45° FOV.
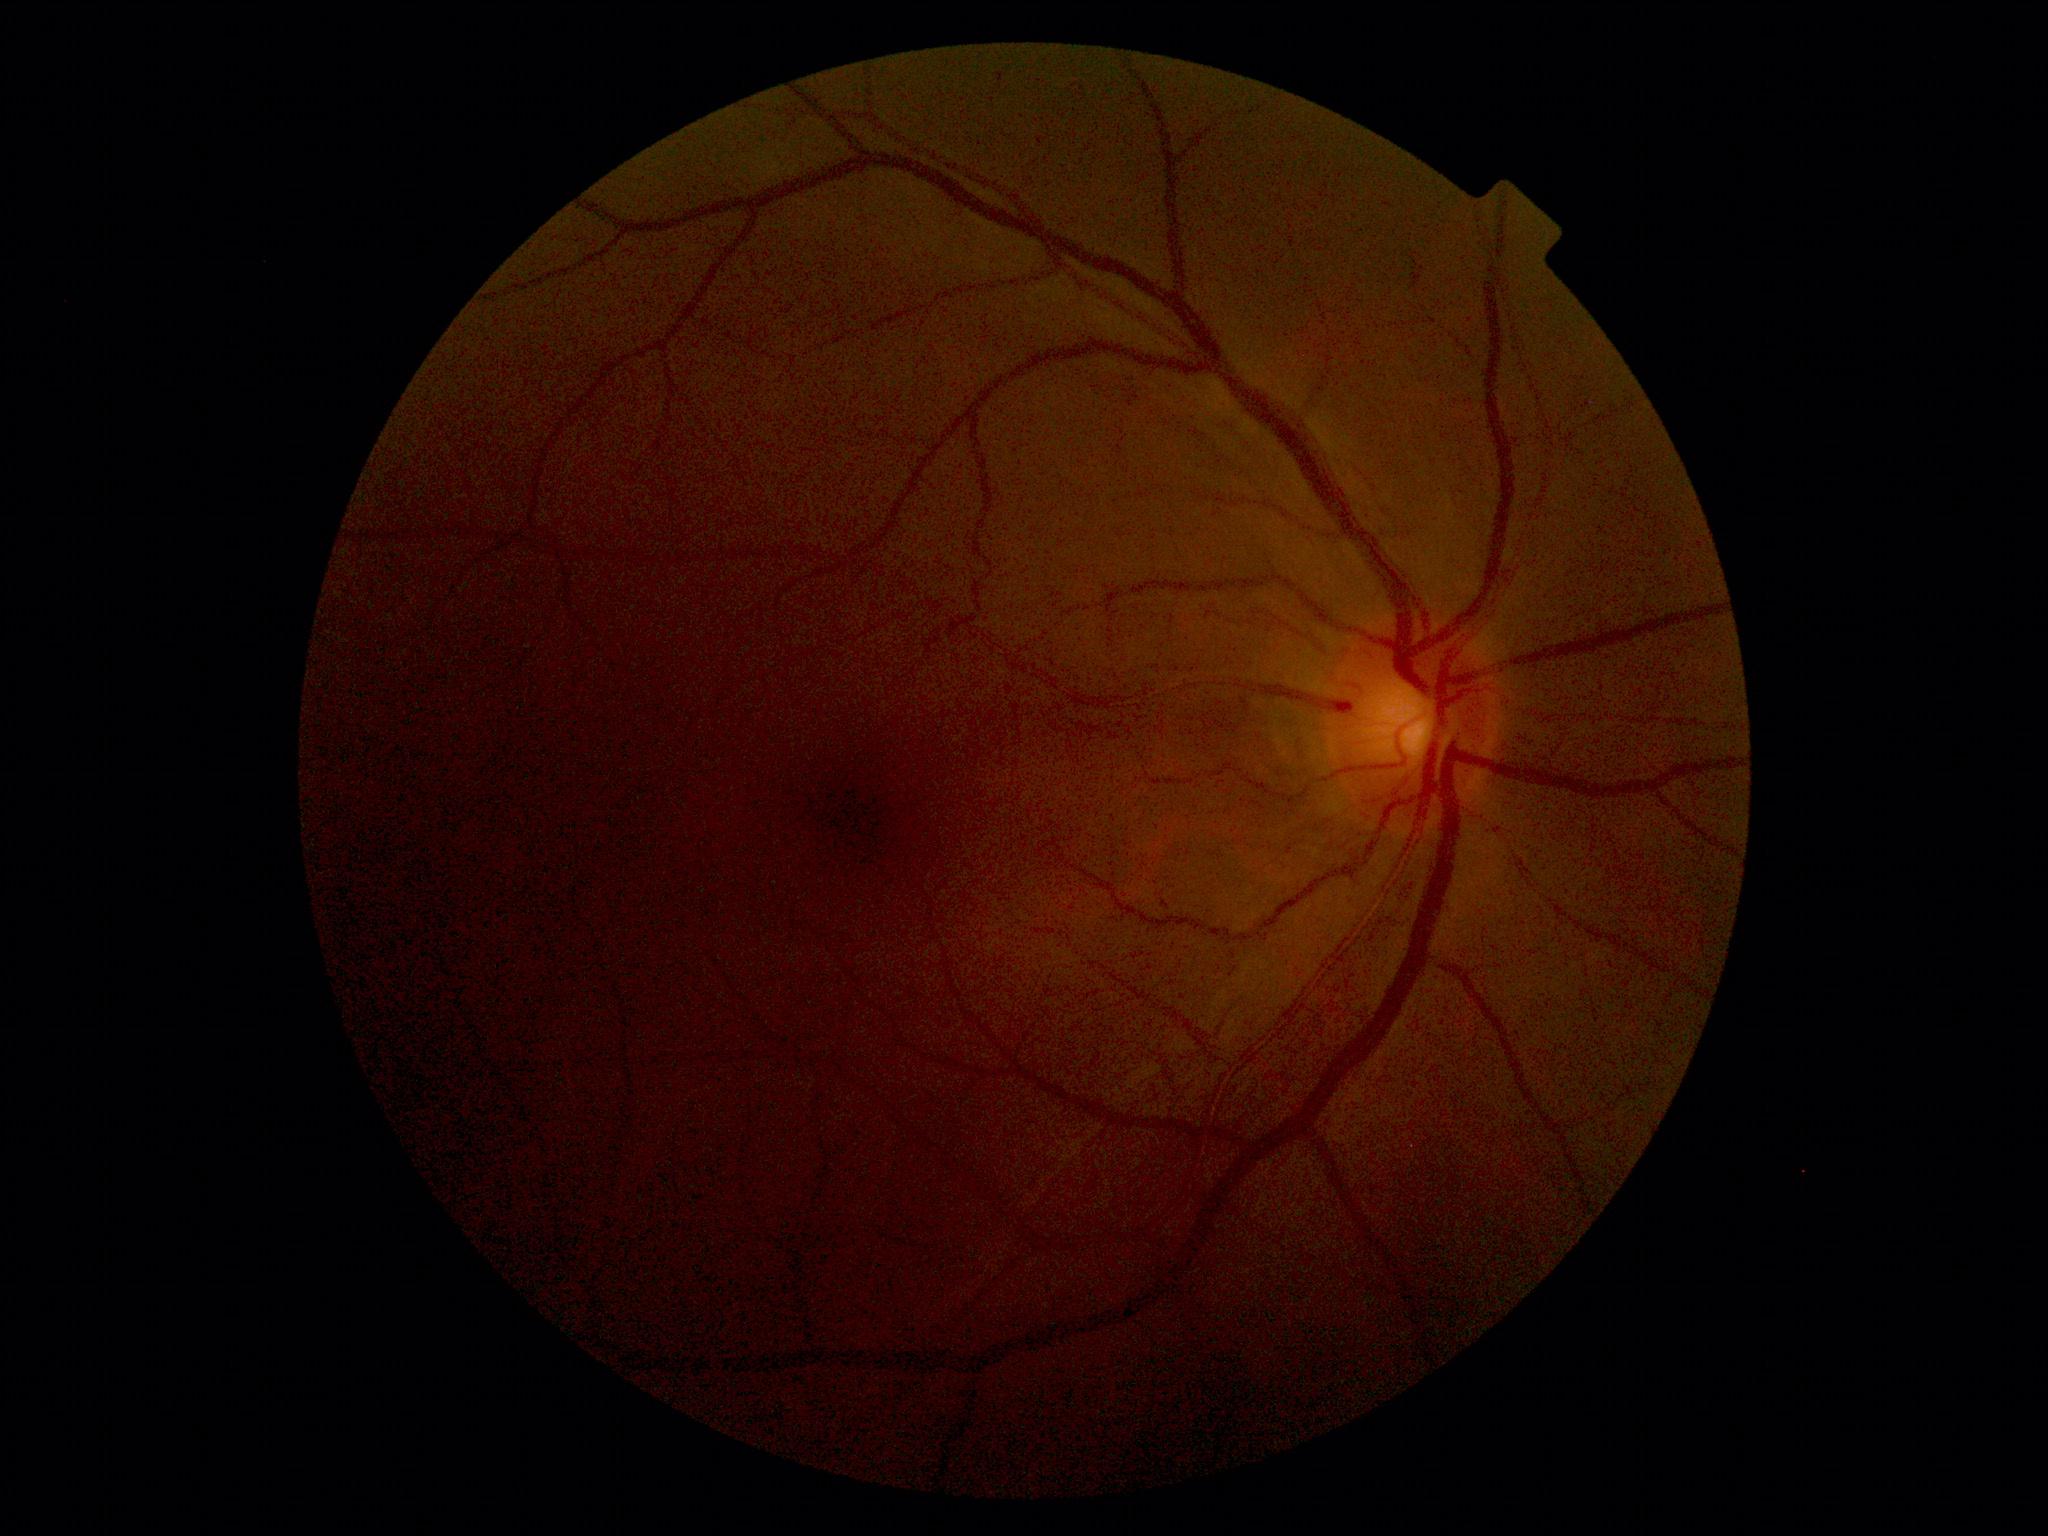
DR = 0, DR impression = negative for DR.